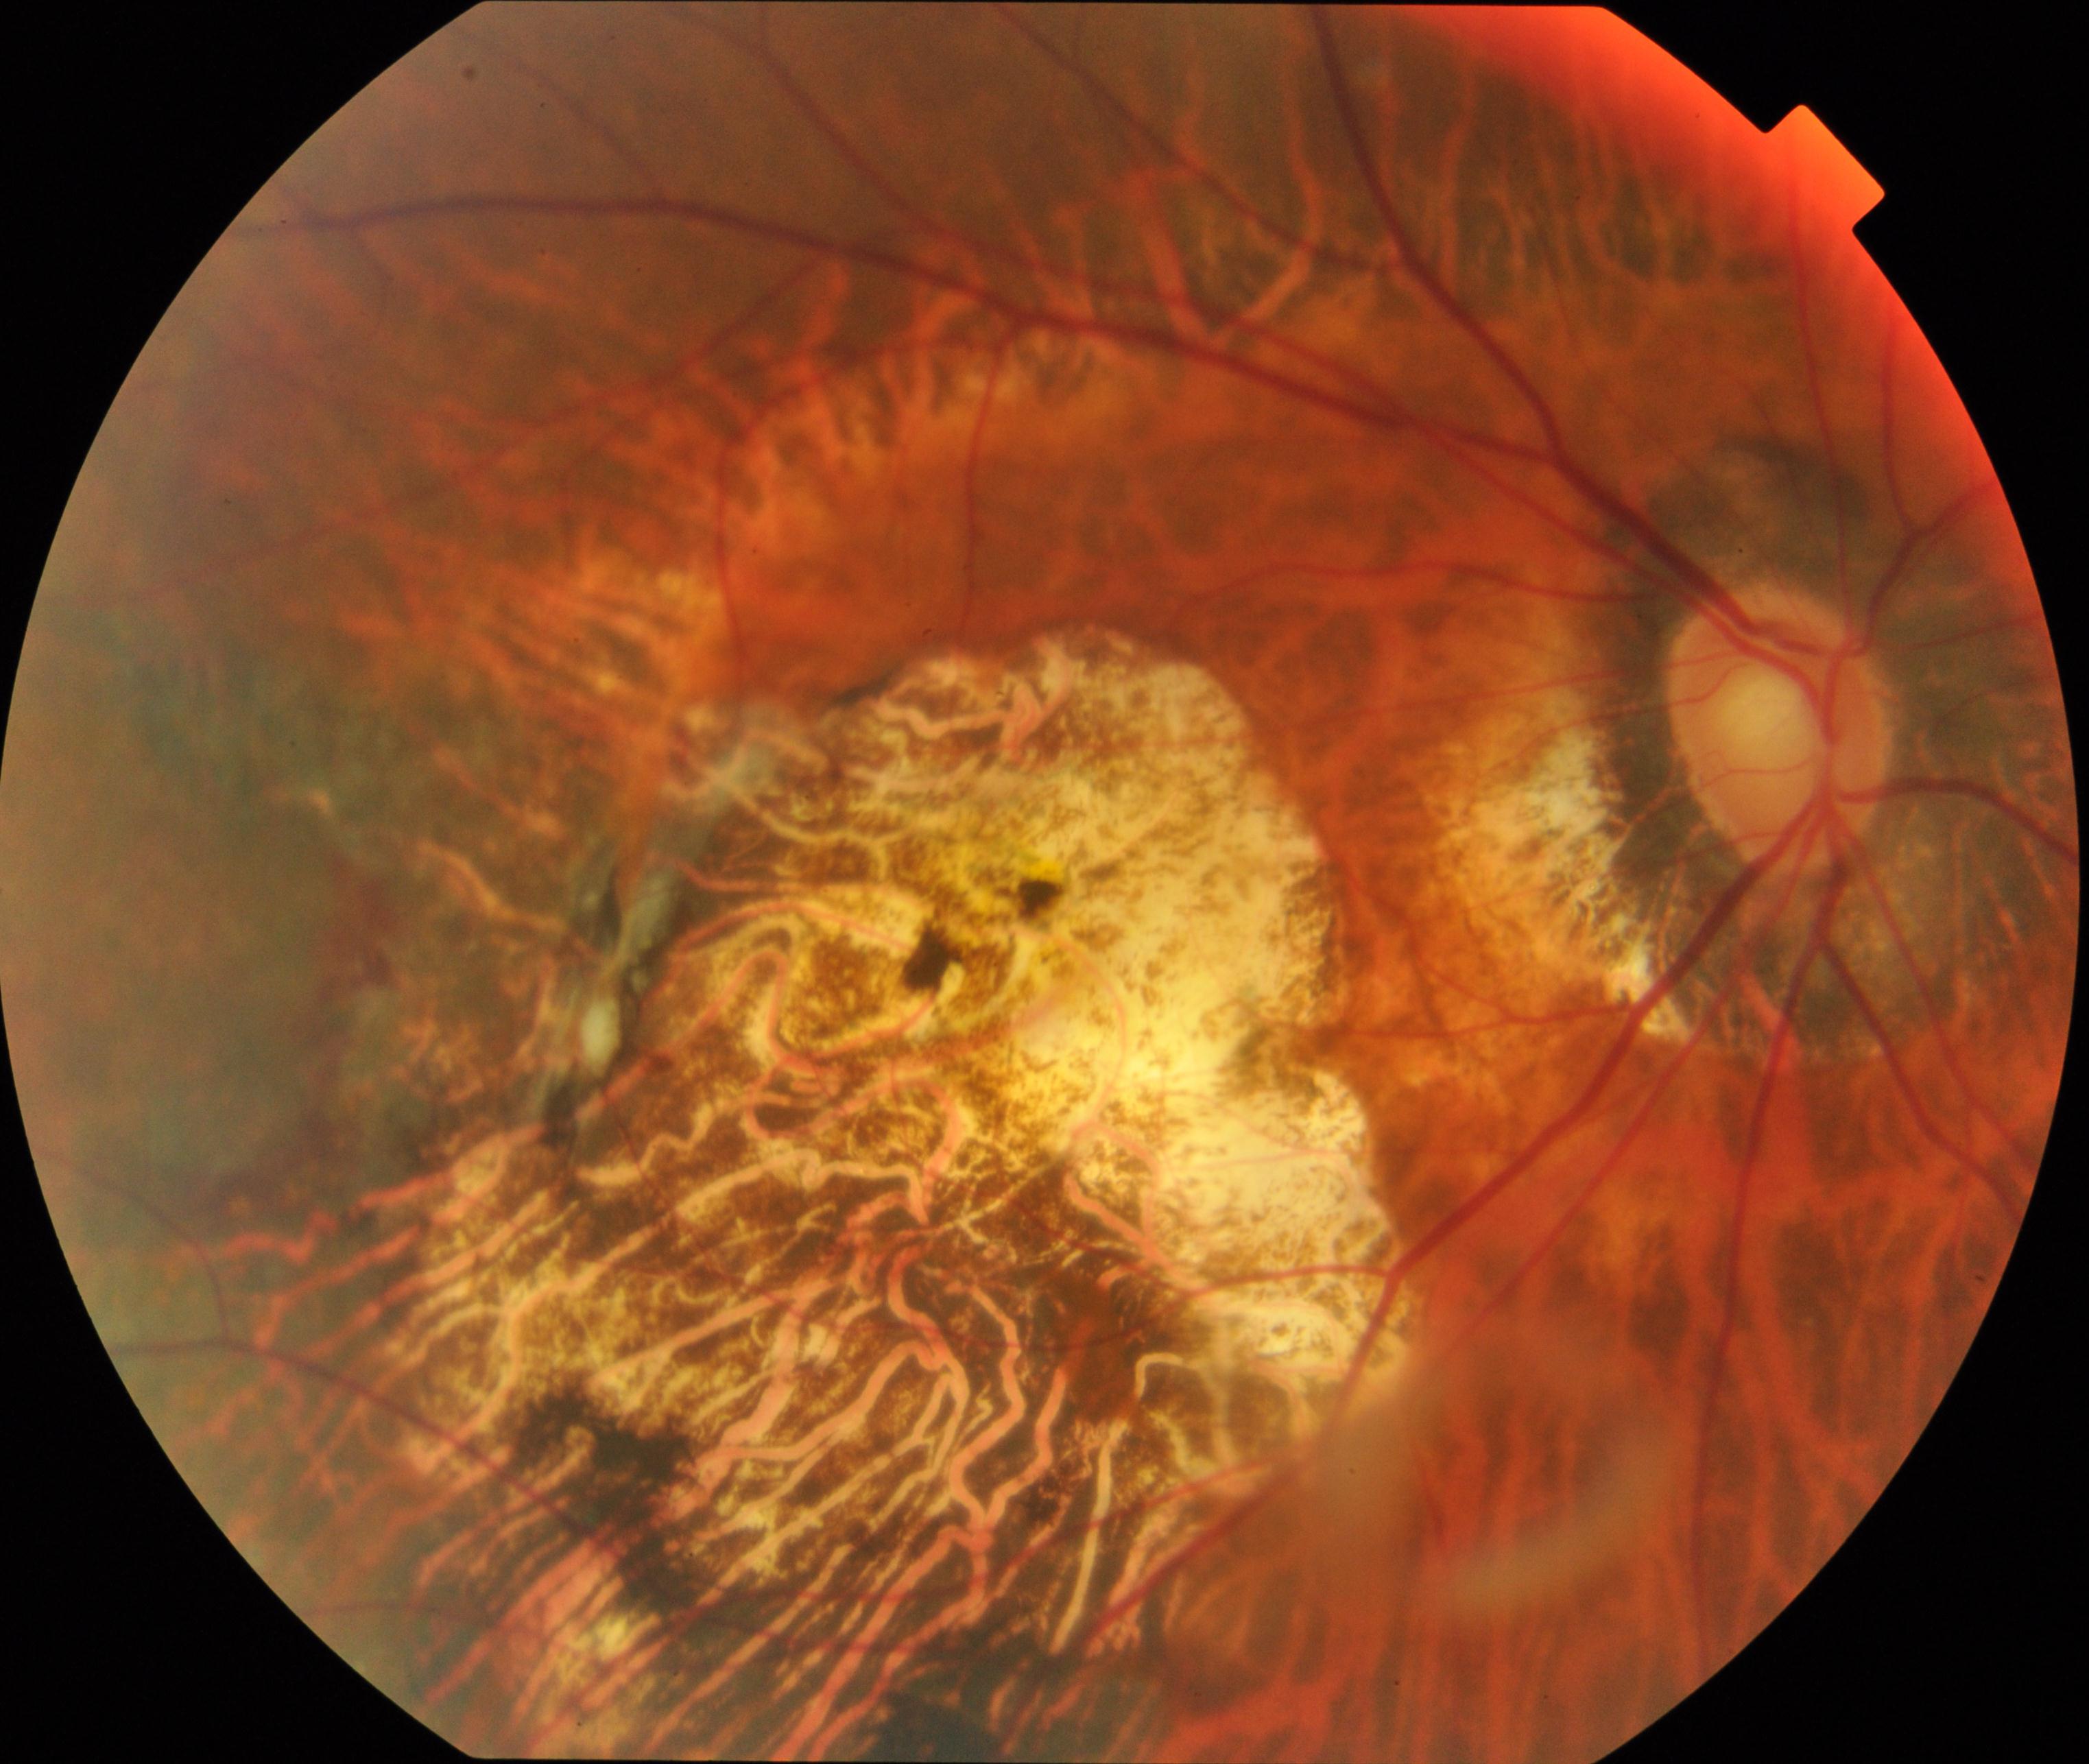

Classification: pathological myopia. Features include tessellated fundus with focal chorioretinal atrophy, Fuchs spot, lacquer cracks, choroidal neovascularization, or subretinal hemorrhage.